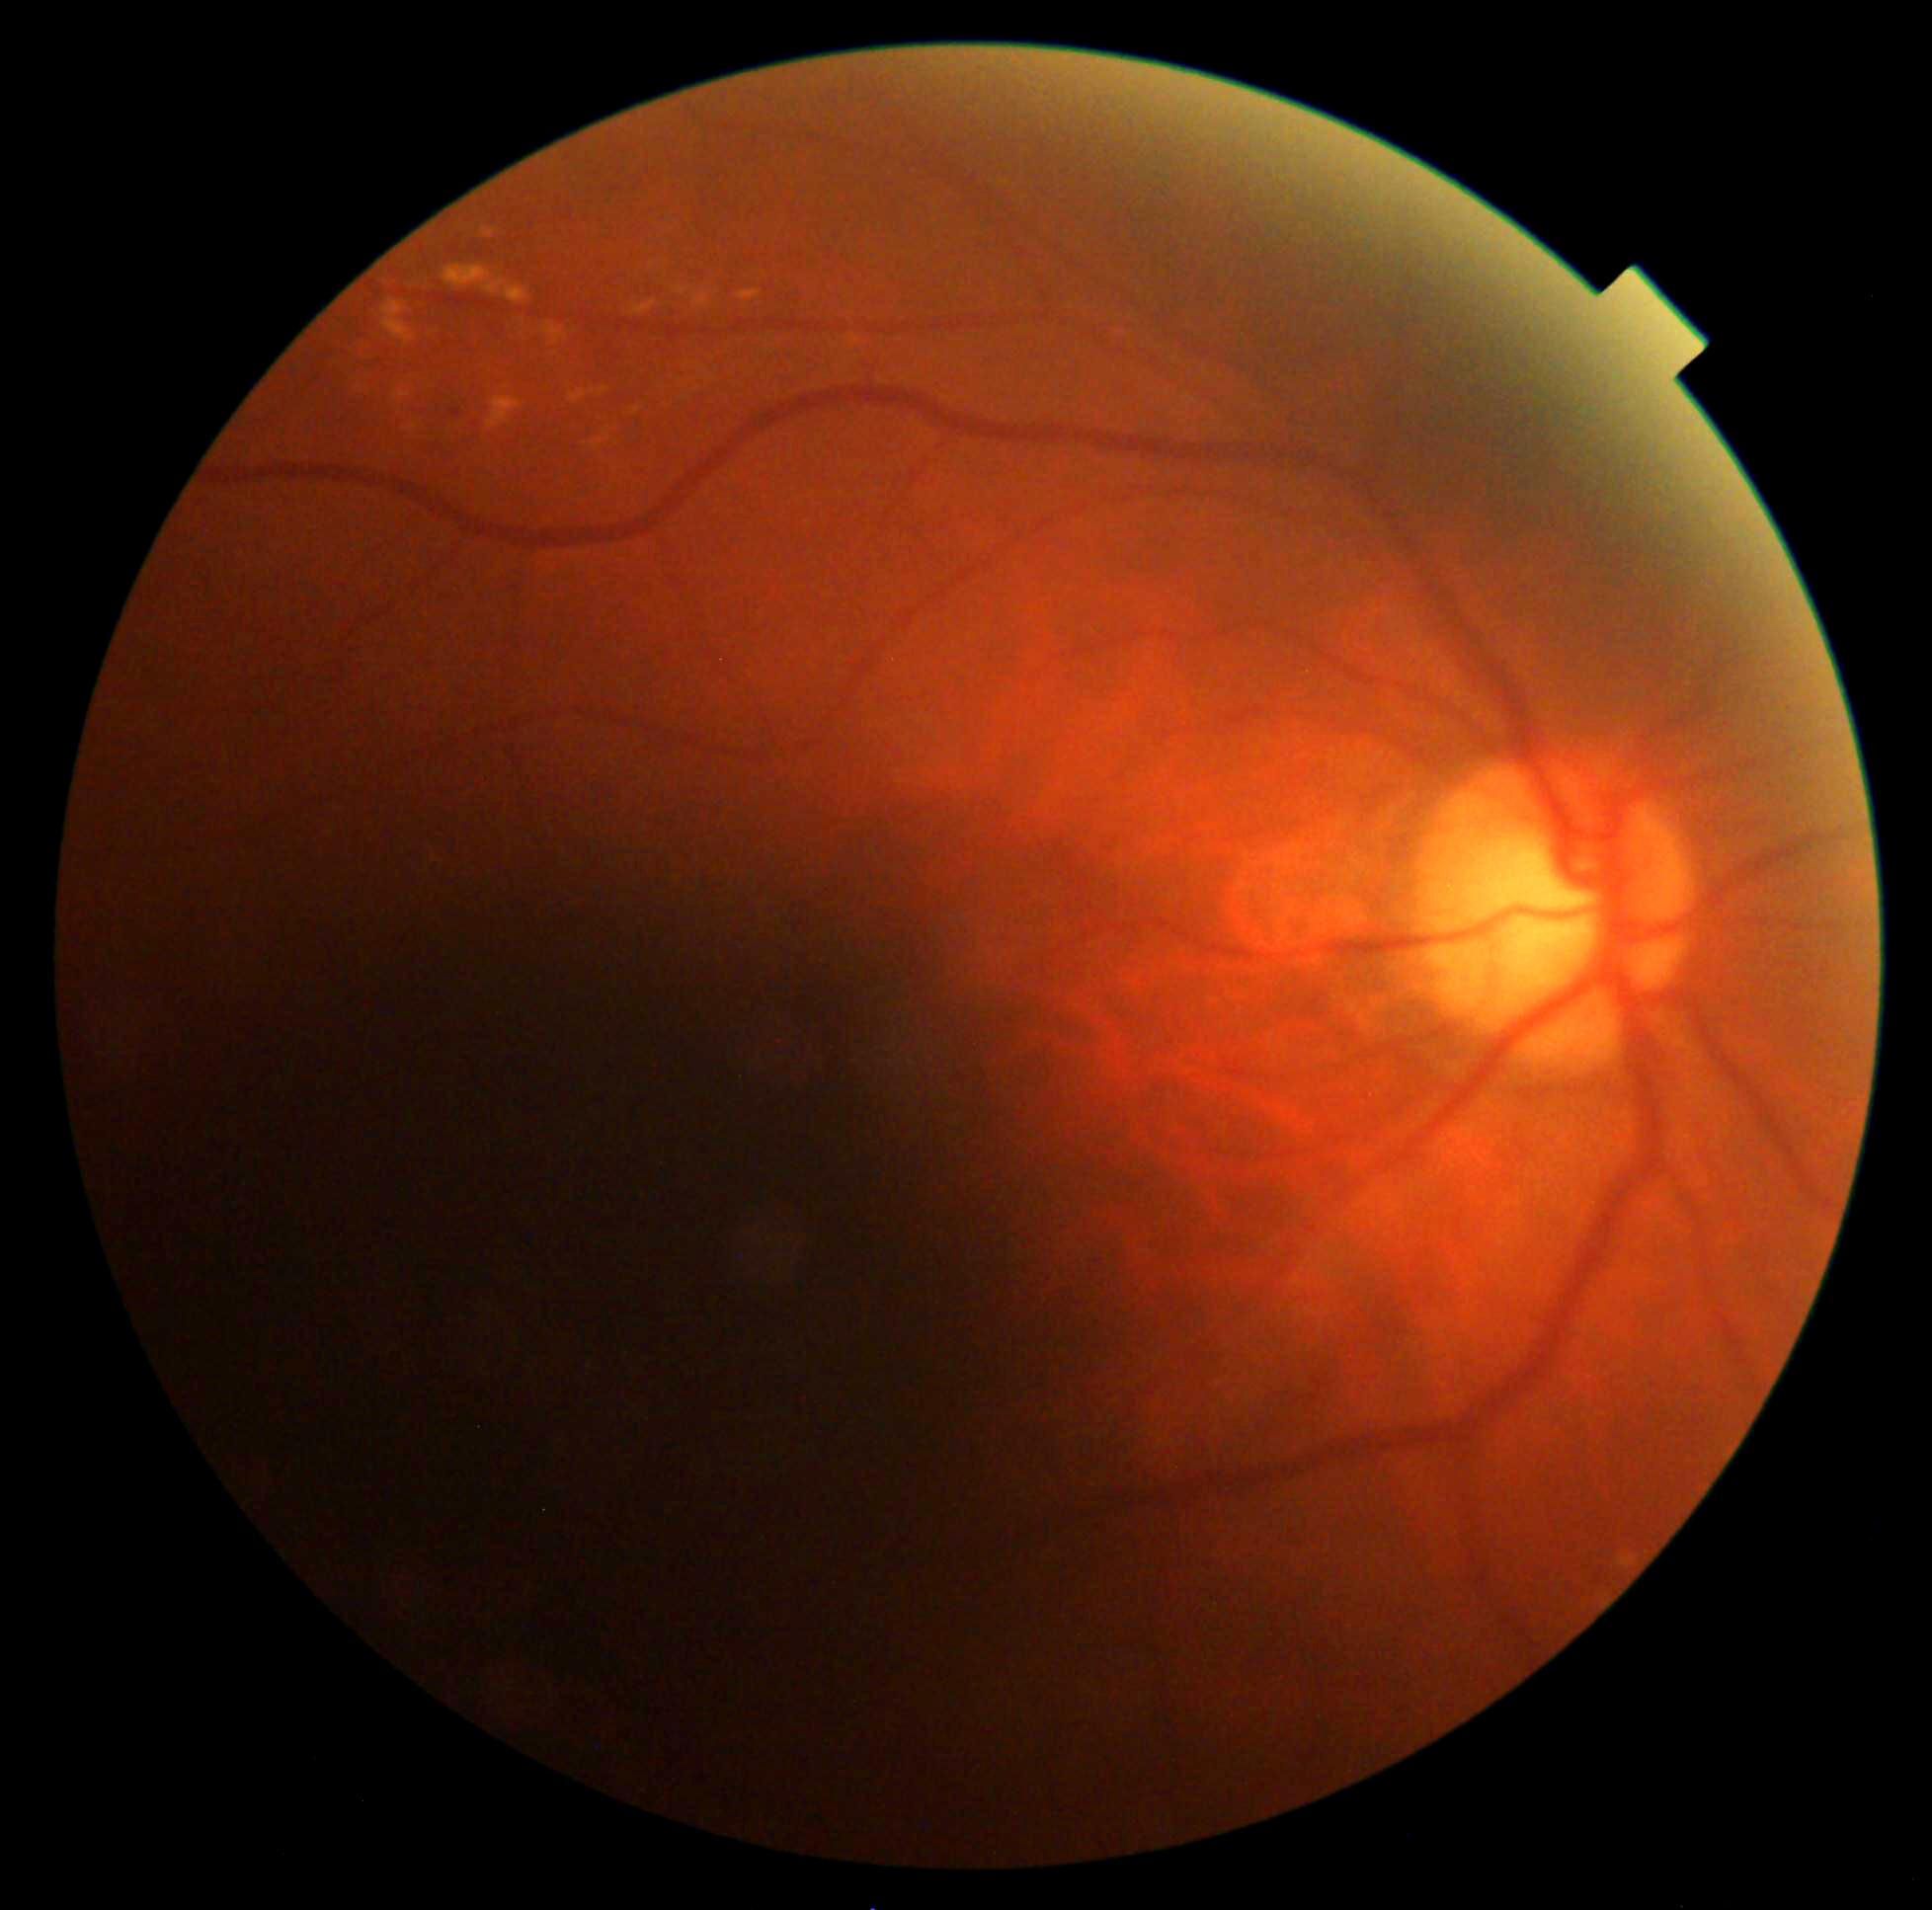

DR class@non-proliferative diabetic retinopathy; diabetic retinopathy severity@grade 2.